Image size 2089x1764 — 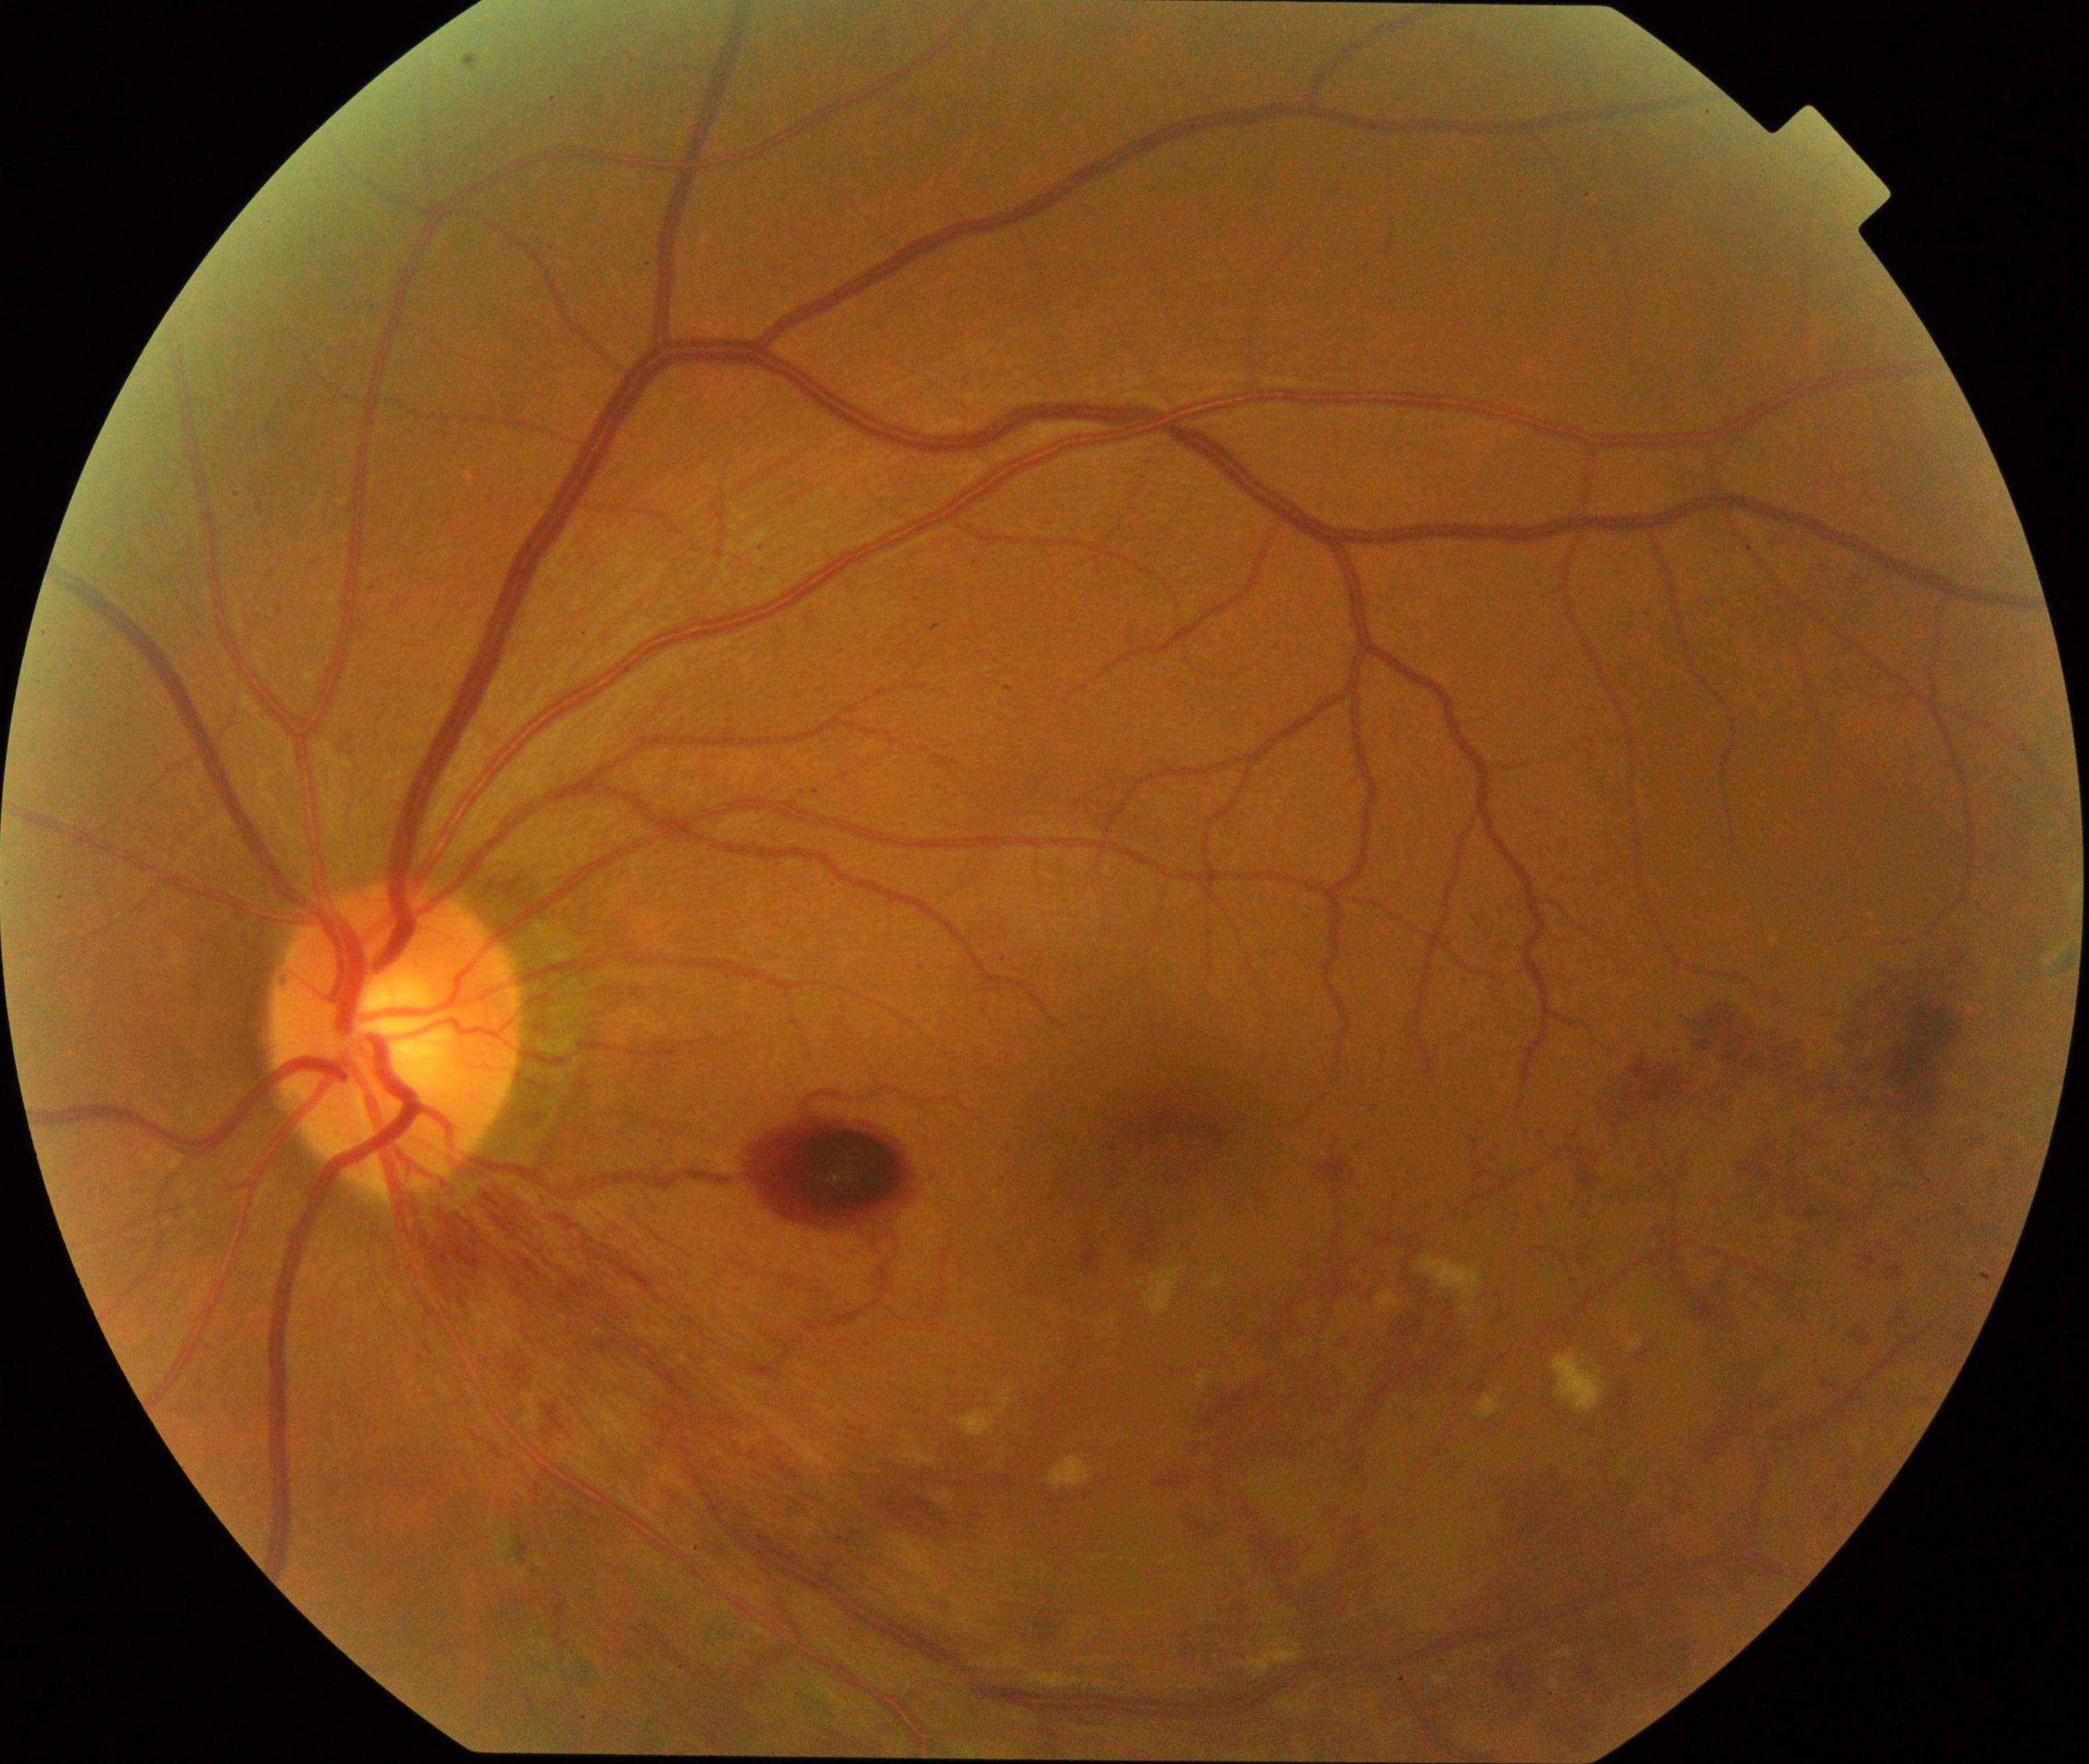 Findings consistent with branch retinal vein occlusion (BRVO).